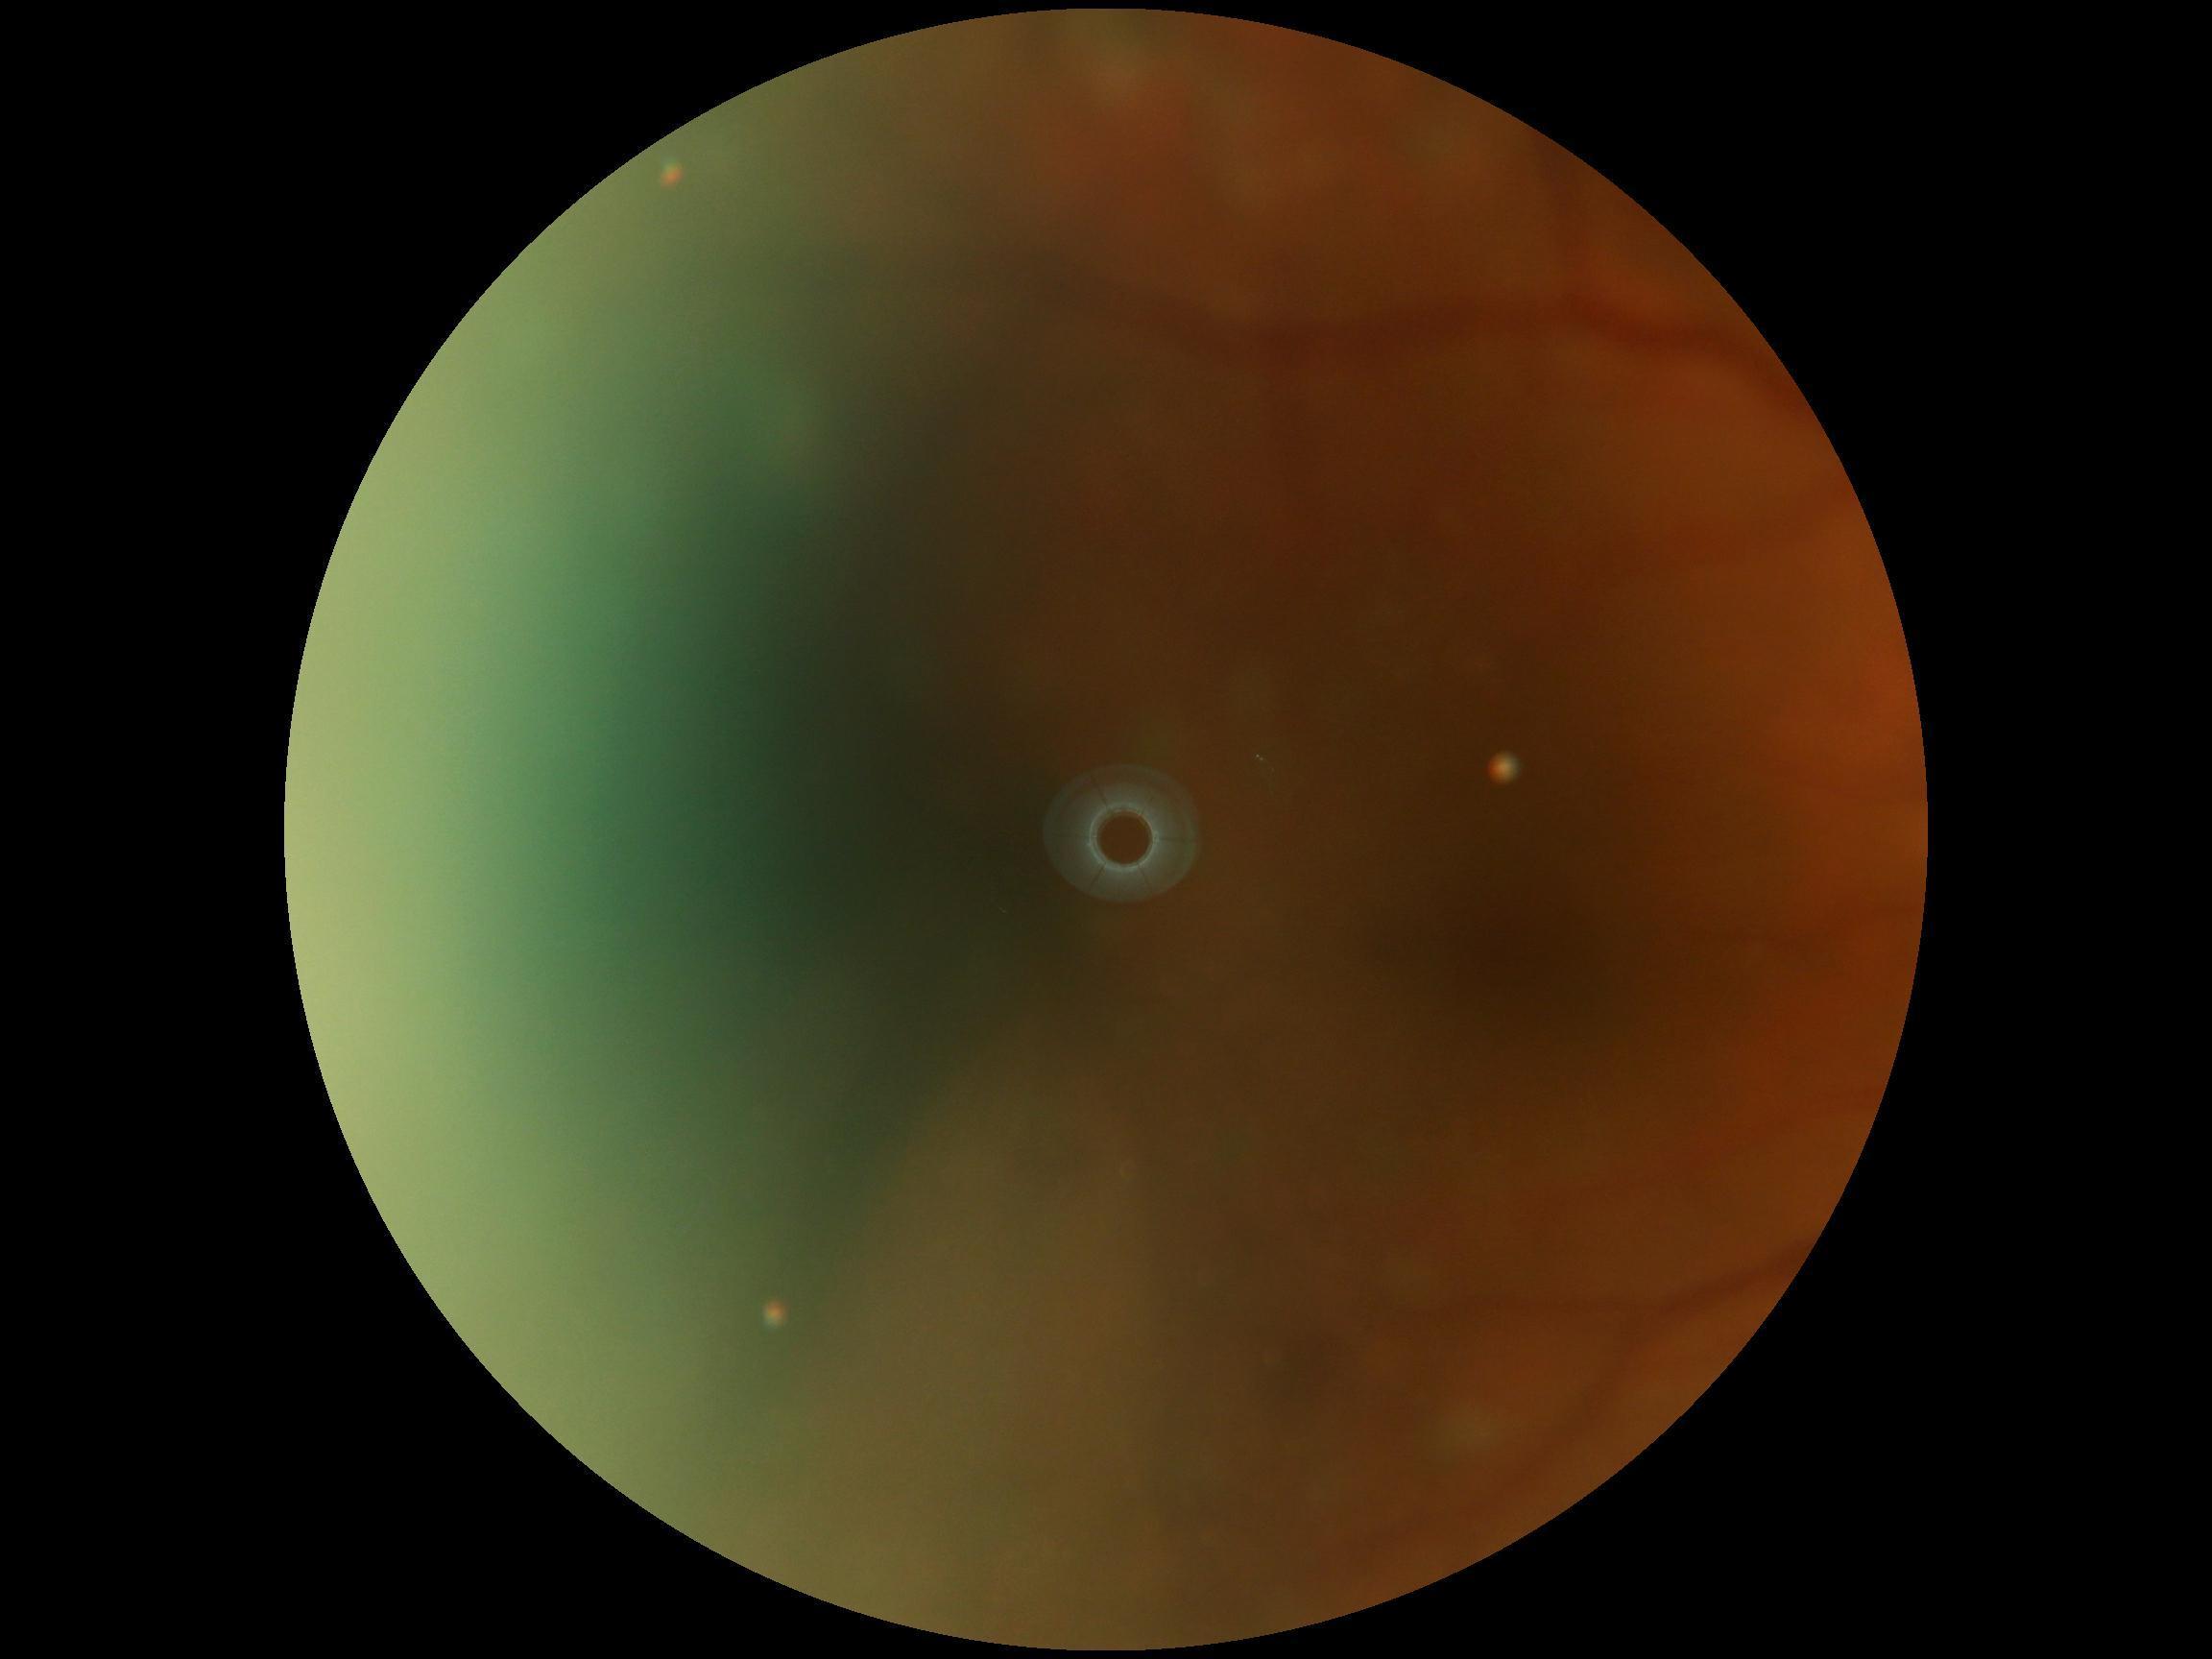 Quality too poor to assess for DR. DR severity is ungradable.